Retinal fundus photograph. Image size 2352x1568.
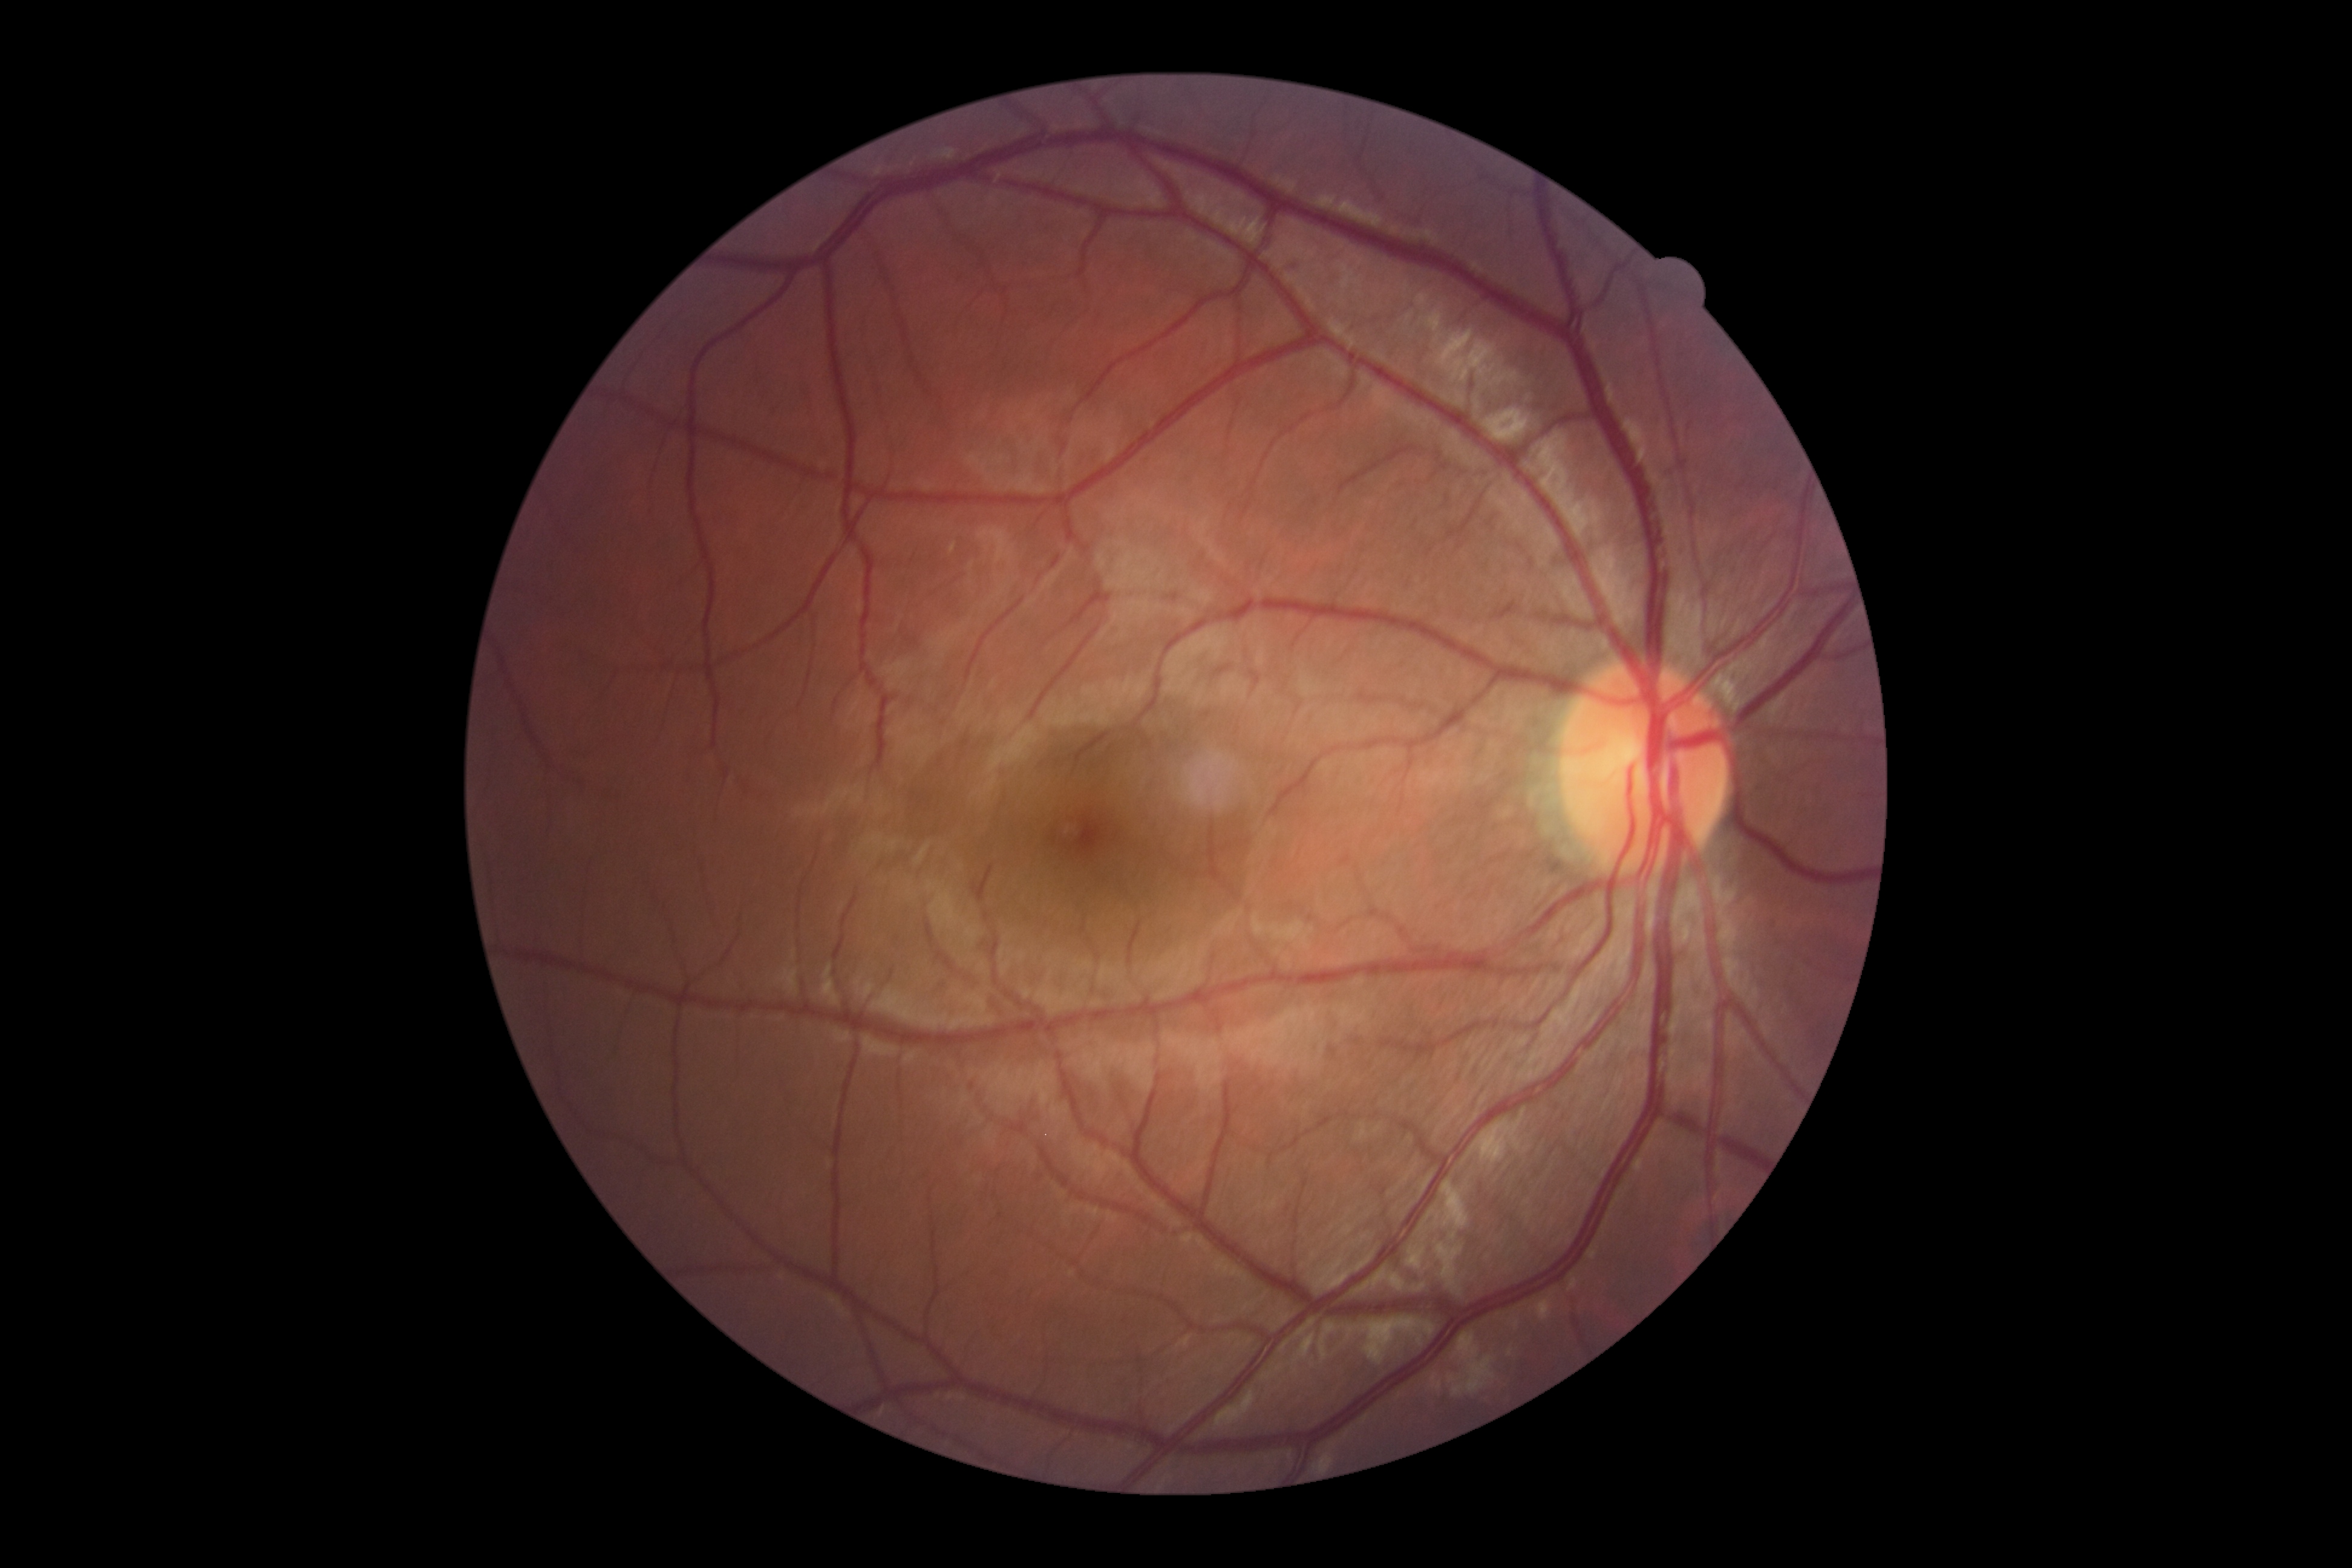 Diabetic retinopathy (DR): 0/4.